Wide-field contact fundus photograph of an infant:
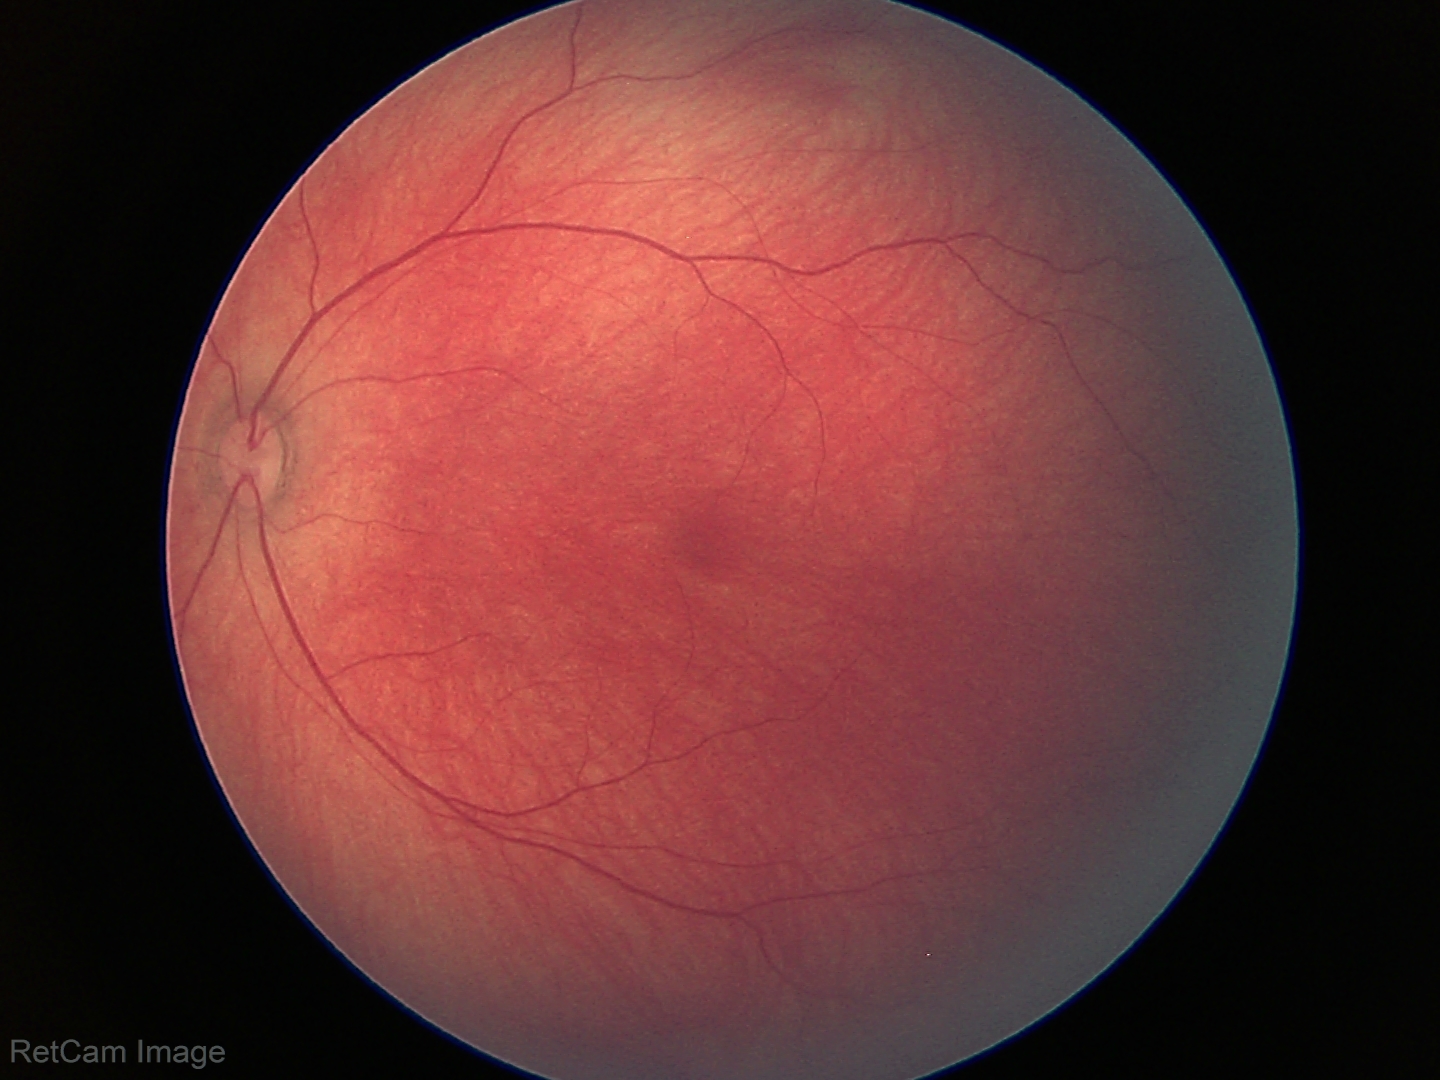

Physiological retinal appearance for postconceptual age.